640x480px · infant wide-field fundus photograph · Clarity RetCam 3, 130° FOV
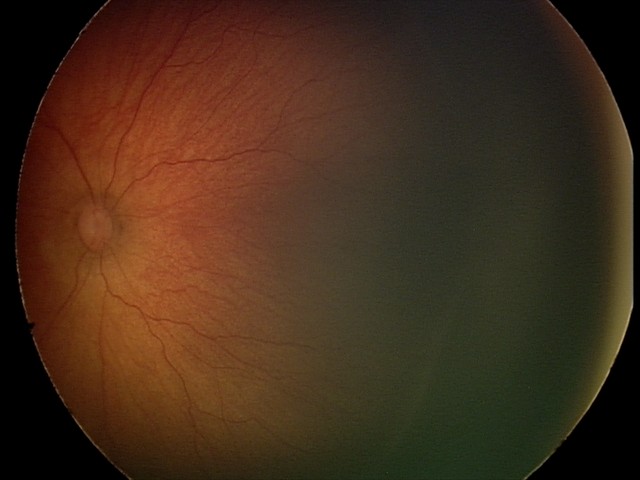 Plus disease absent.
Screening series with ROP stage 2.